45° FOV; 2352 by 1568 pixels:
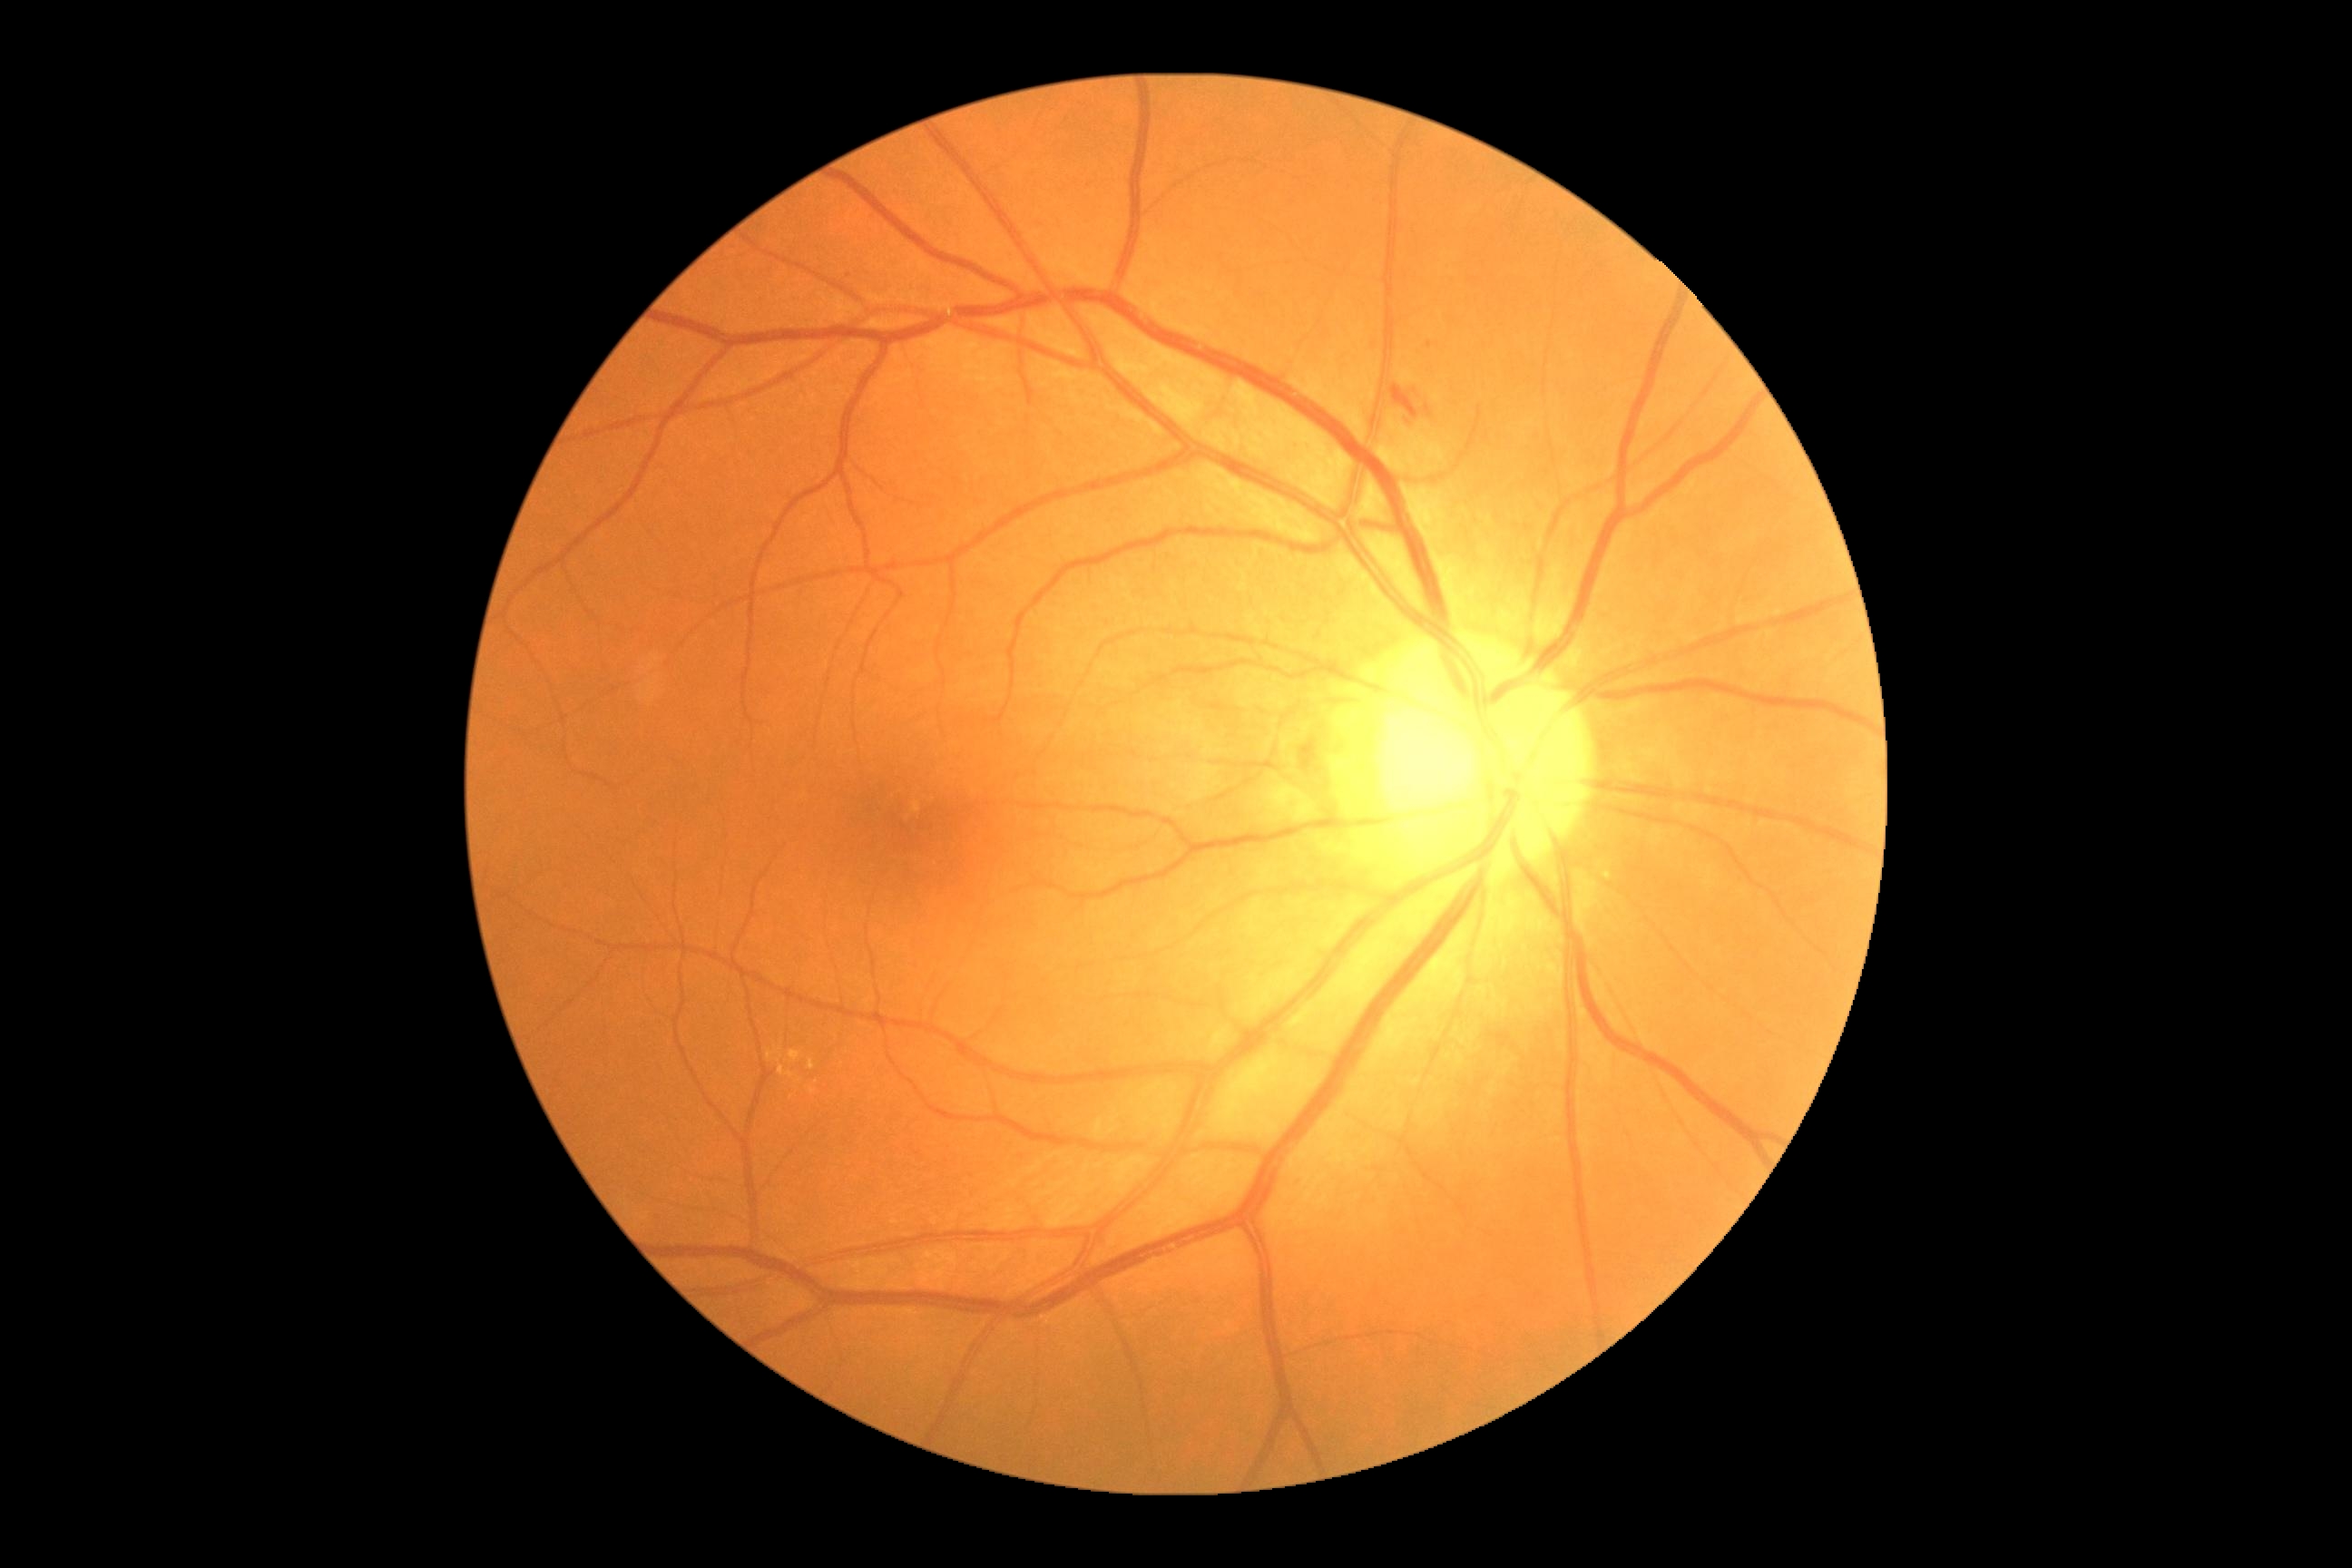

Diabetic retinopathy severity is moderate non-proliferative diabetic retinopathy (grade 2) — more than just microaneurysms but less than severe NPDR.